848 by 848 pixels
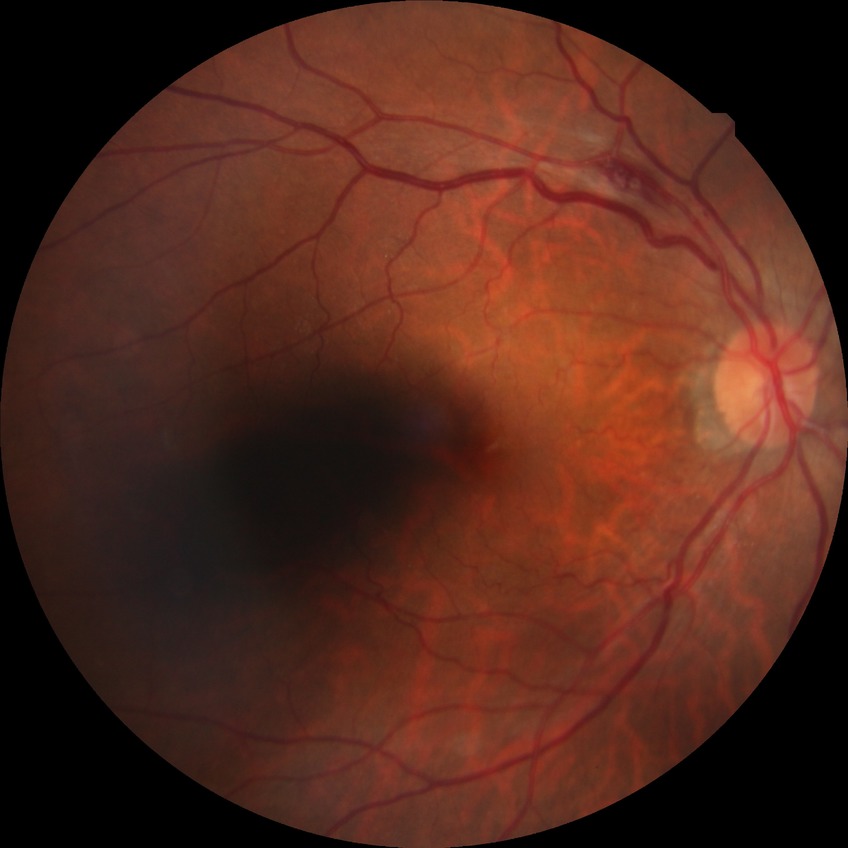
diabetic retinopathy (DR)@NDR (no diabetic retinopathy).